NIDEK AFC-230 fundus camera · nonmydriatic · CFP · image size 848x848
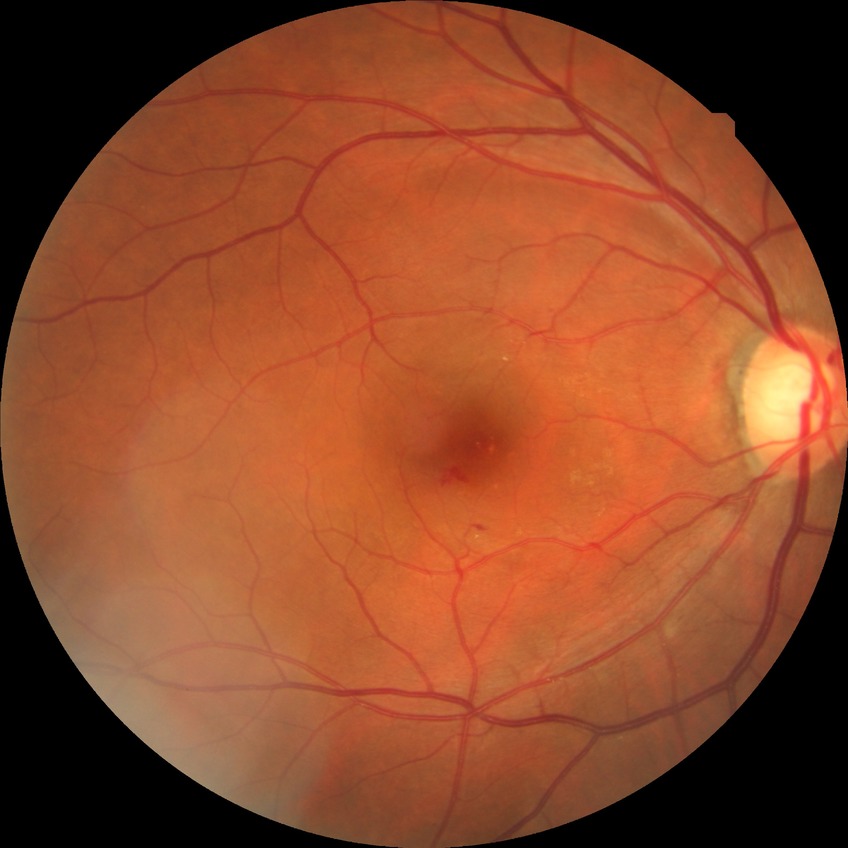 {
  "davis_grade": "NDR"
}